Fundus photo.
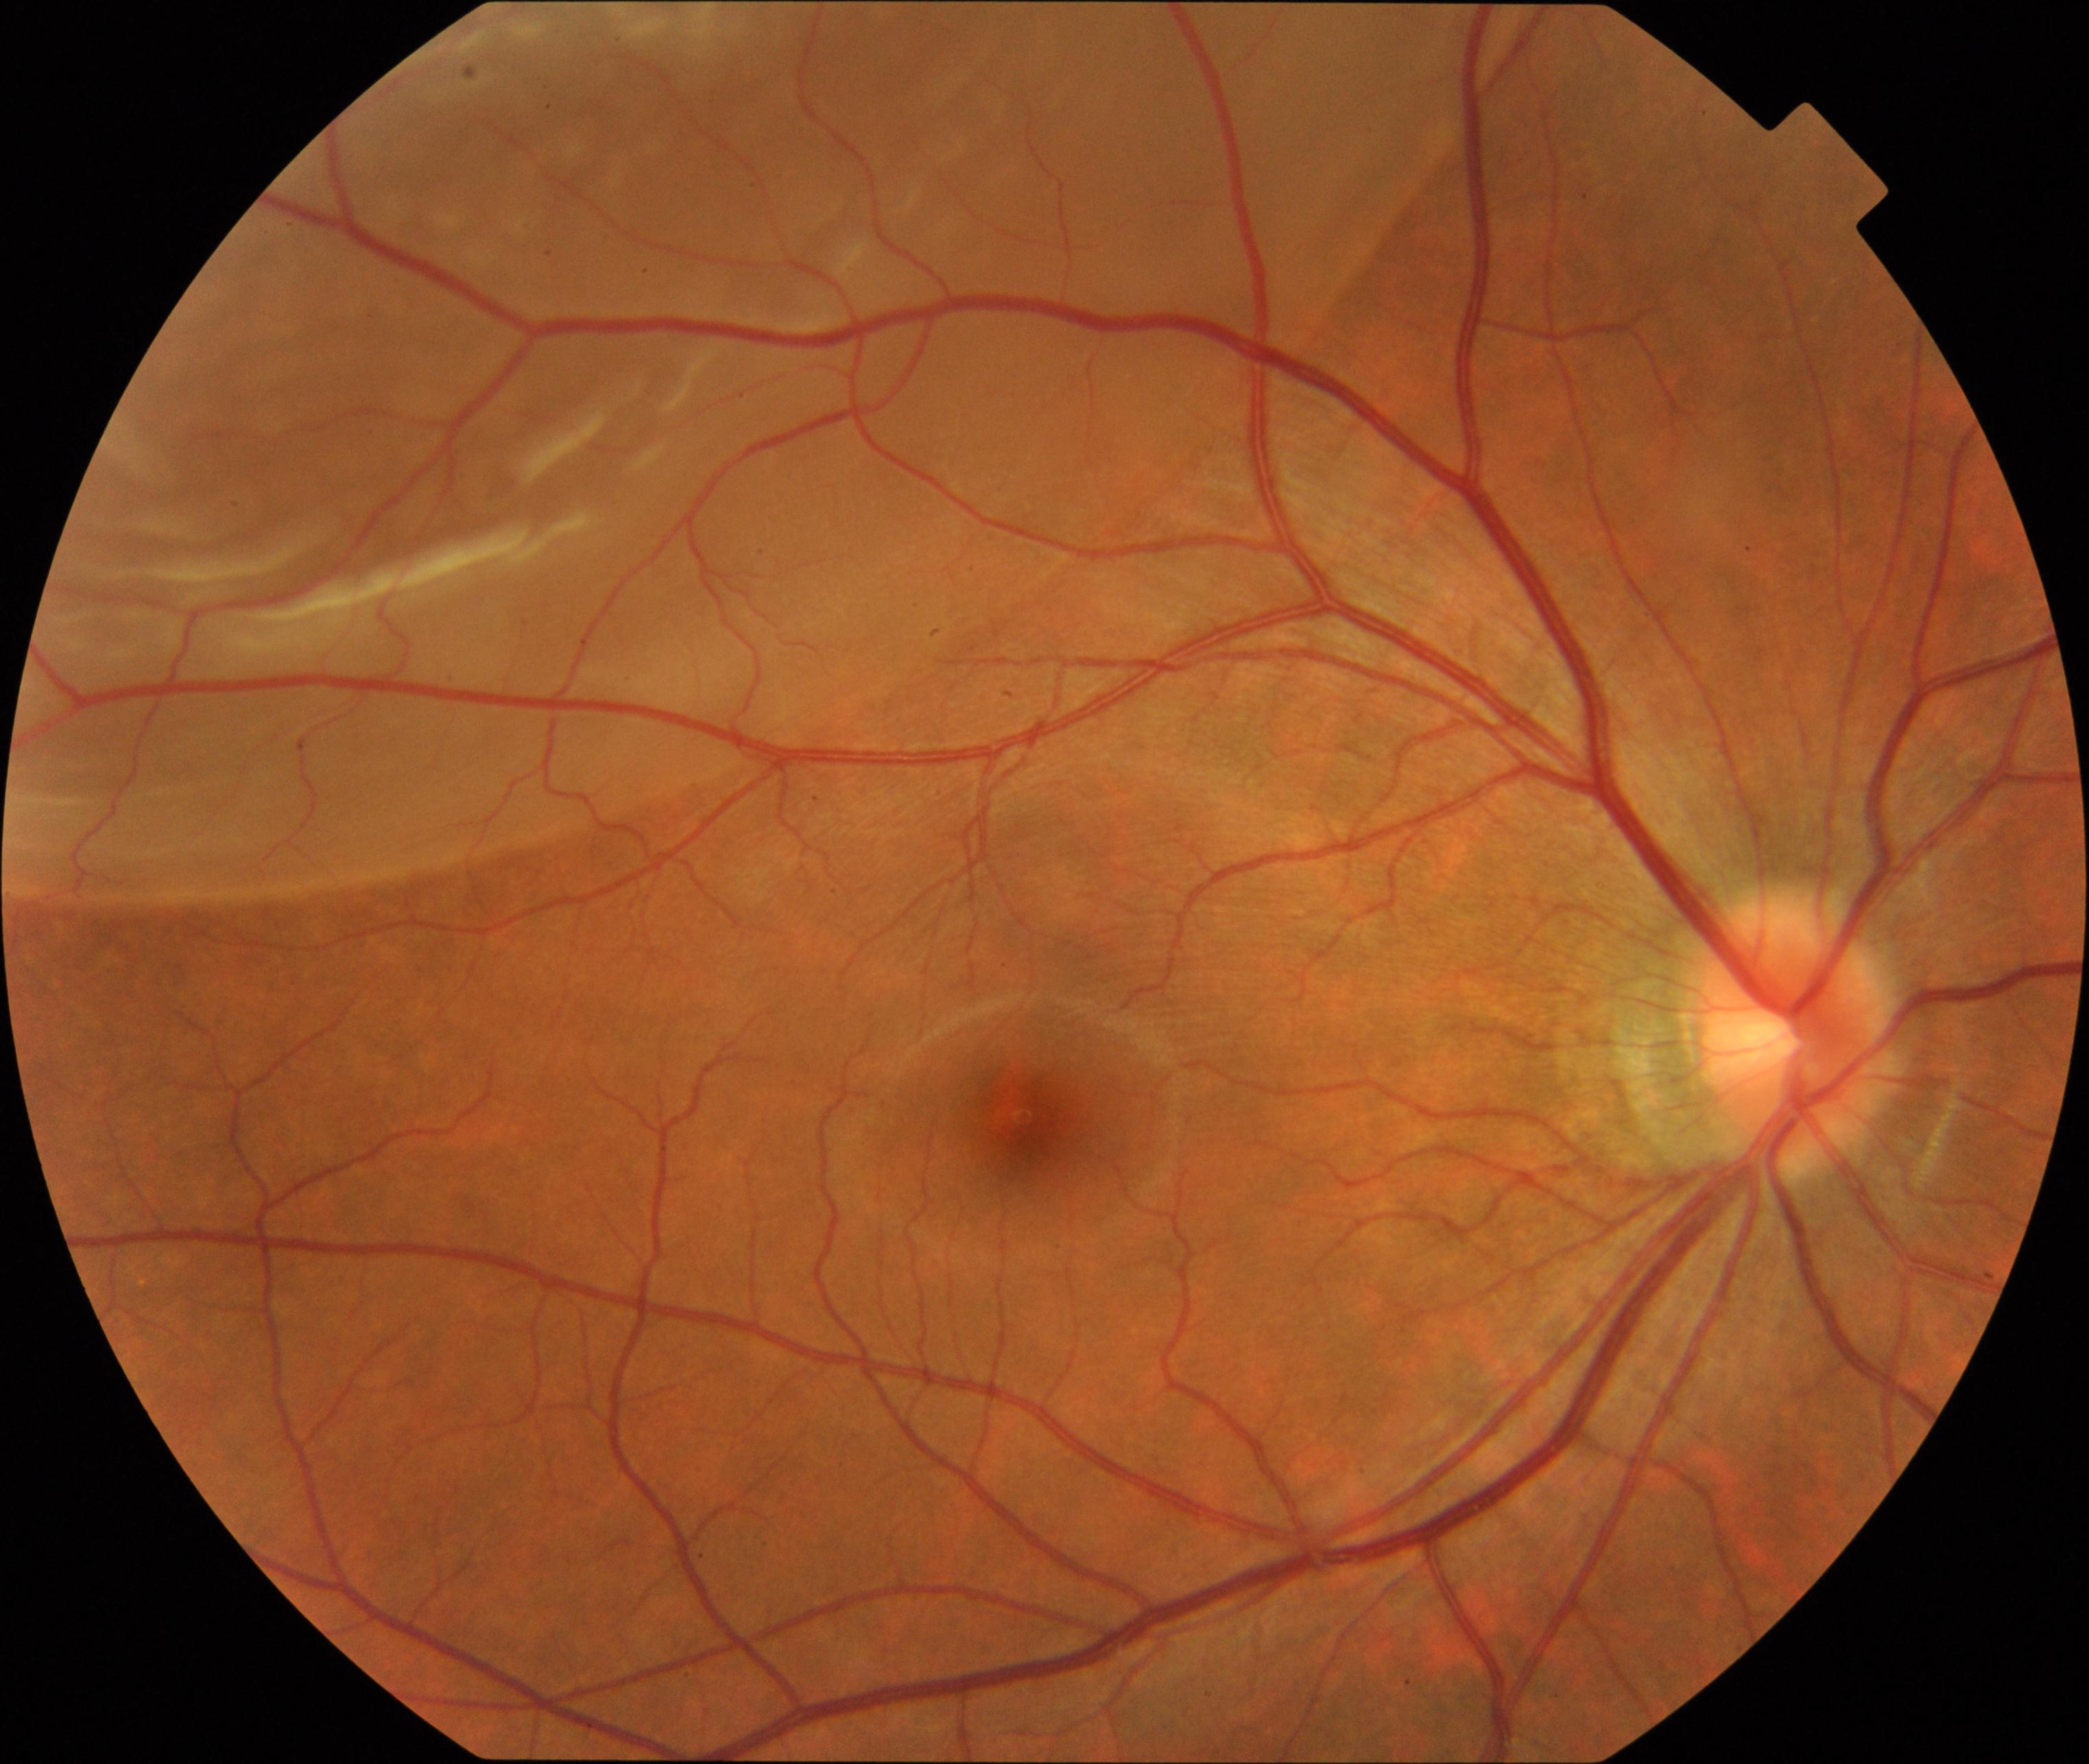
The image shows rhegmatogenous retinal detachment.